848x848. Modified Davis classification. Posterior pole photograph
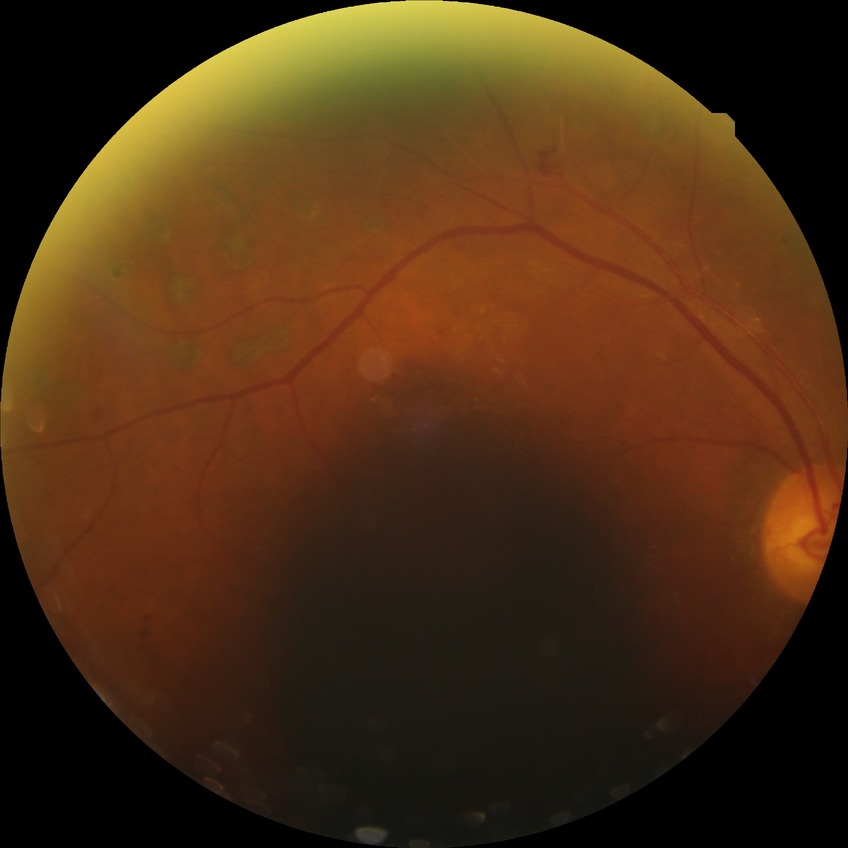
Modified Davis grading is proliferative diabetic retinopathy.